Posterior pole photograph: 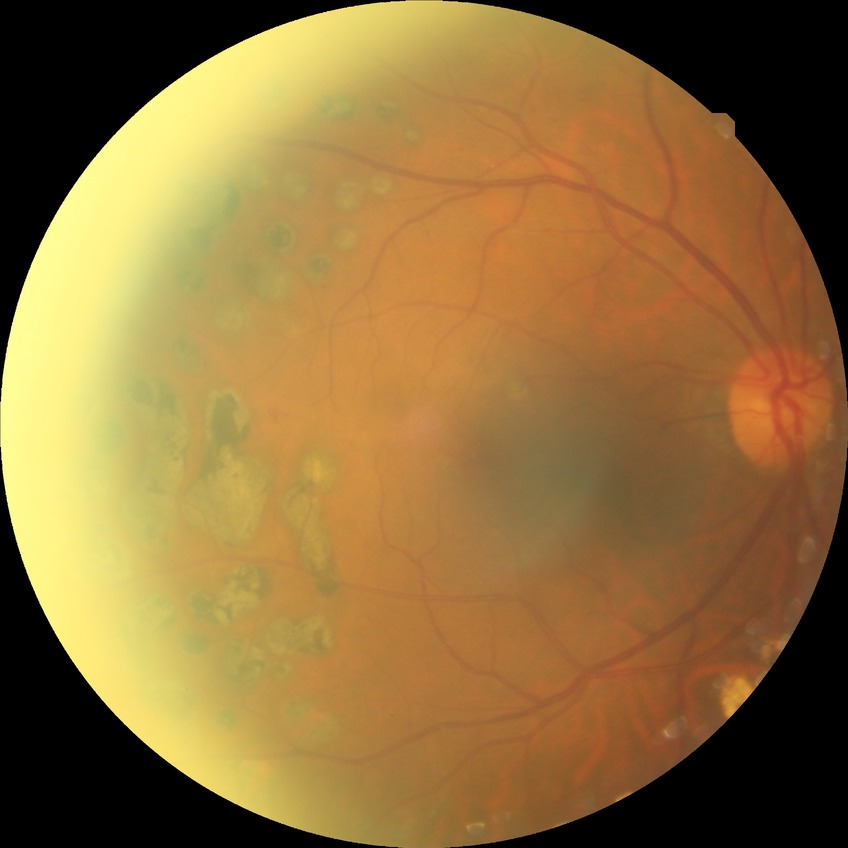
diabetic retinopathy (DR): proliferative diabetic retinopathy (PDR).